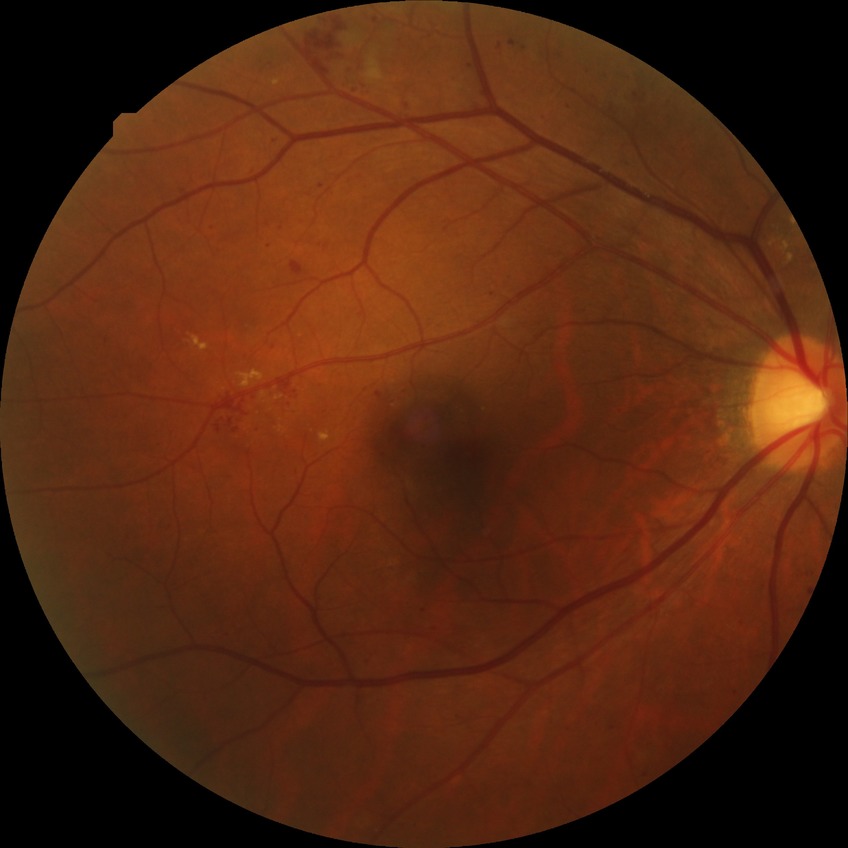 The retinopathy is classified as non-proliferative diabetic retinopathy. Diabetic retinopathy (DR) is pre-proliferative diabetic retinopathy (PPDR).